Color fundus photograph
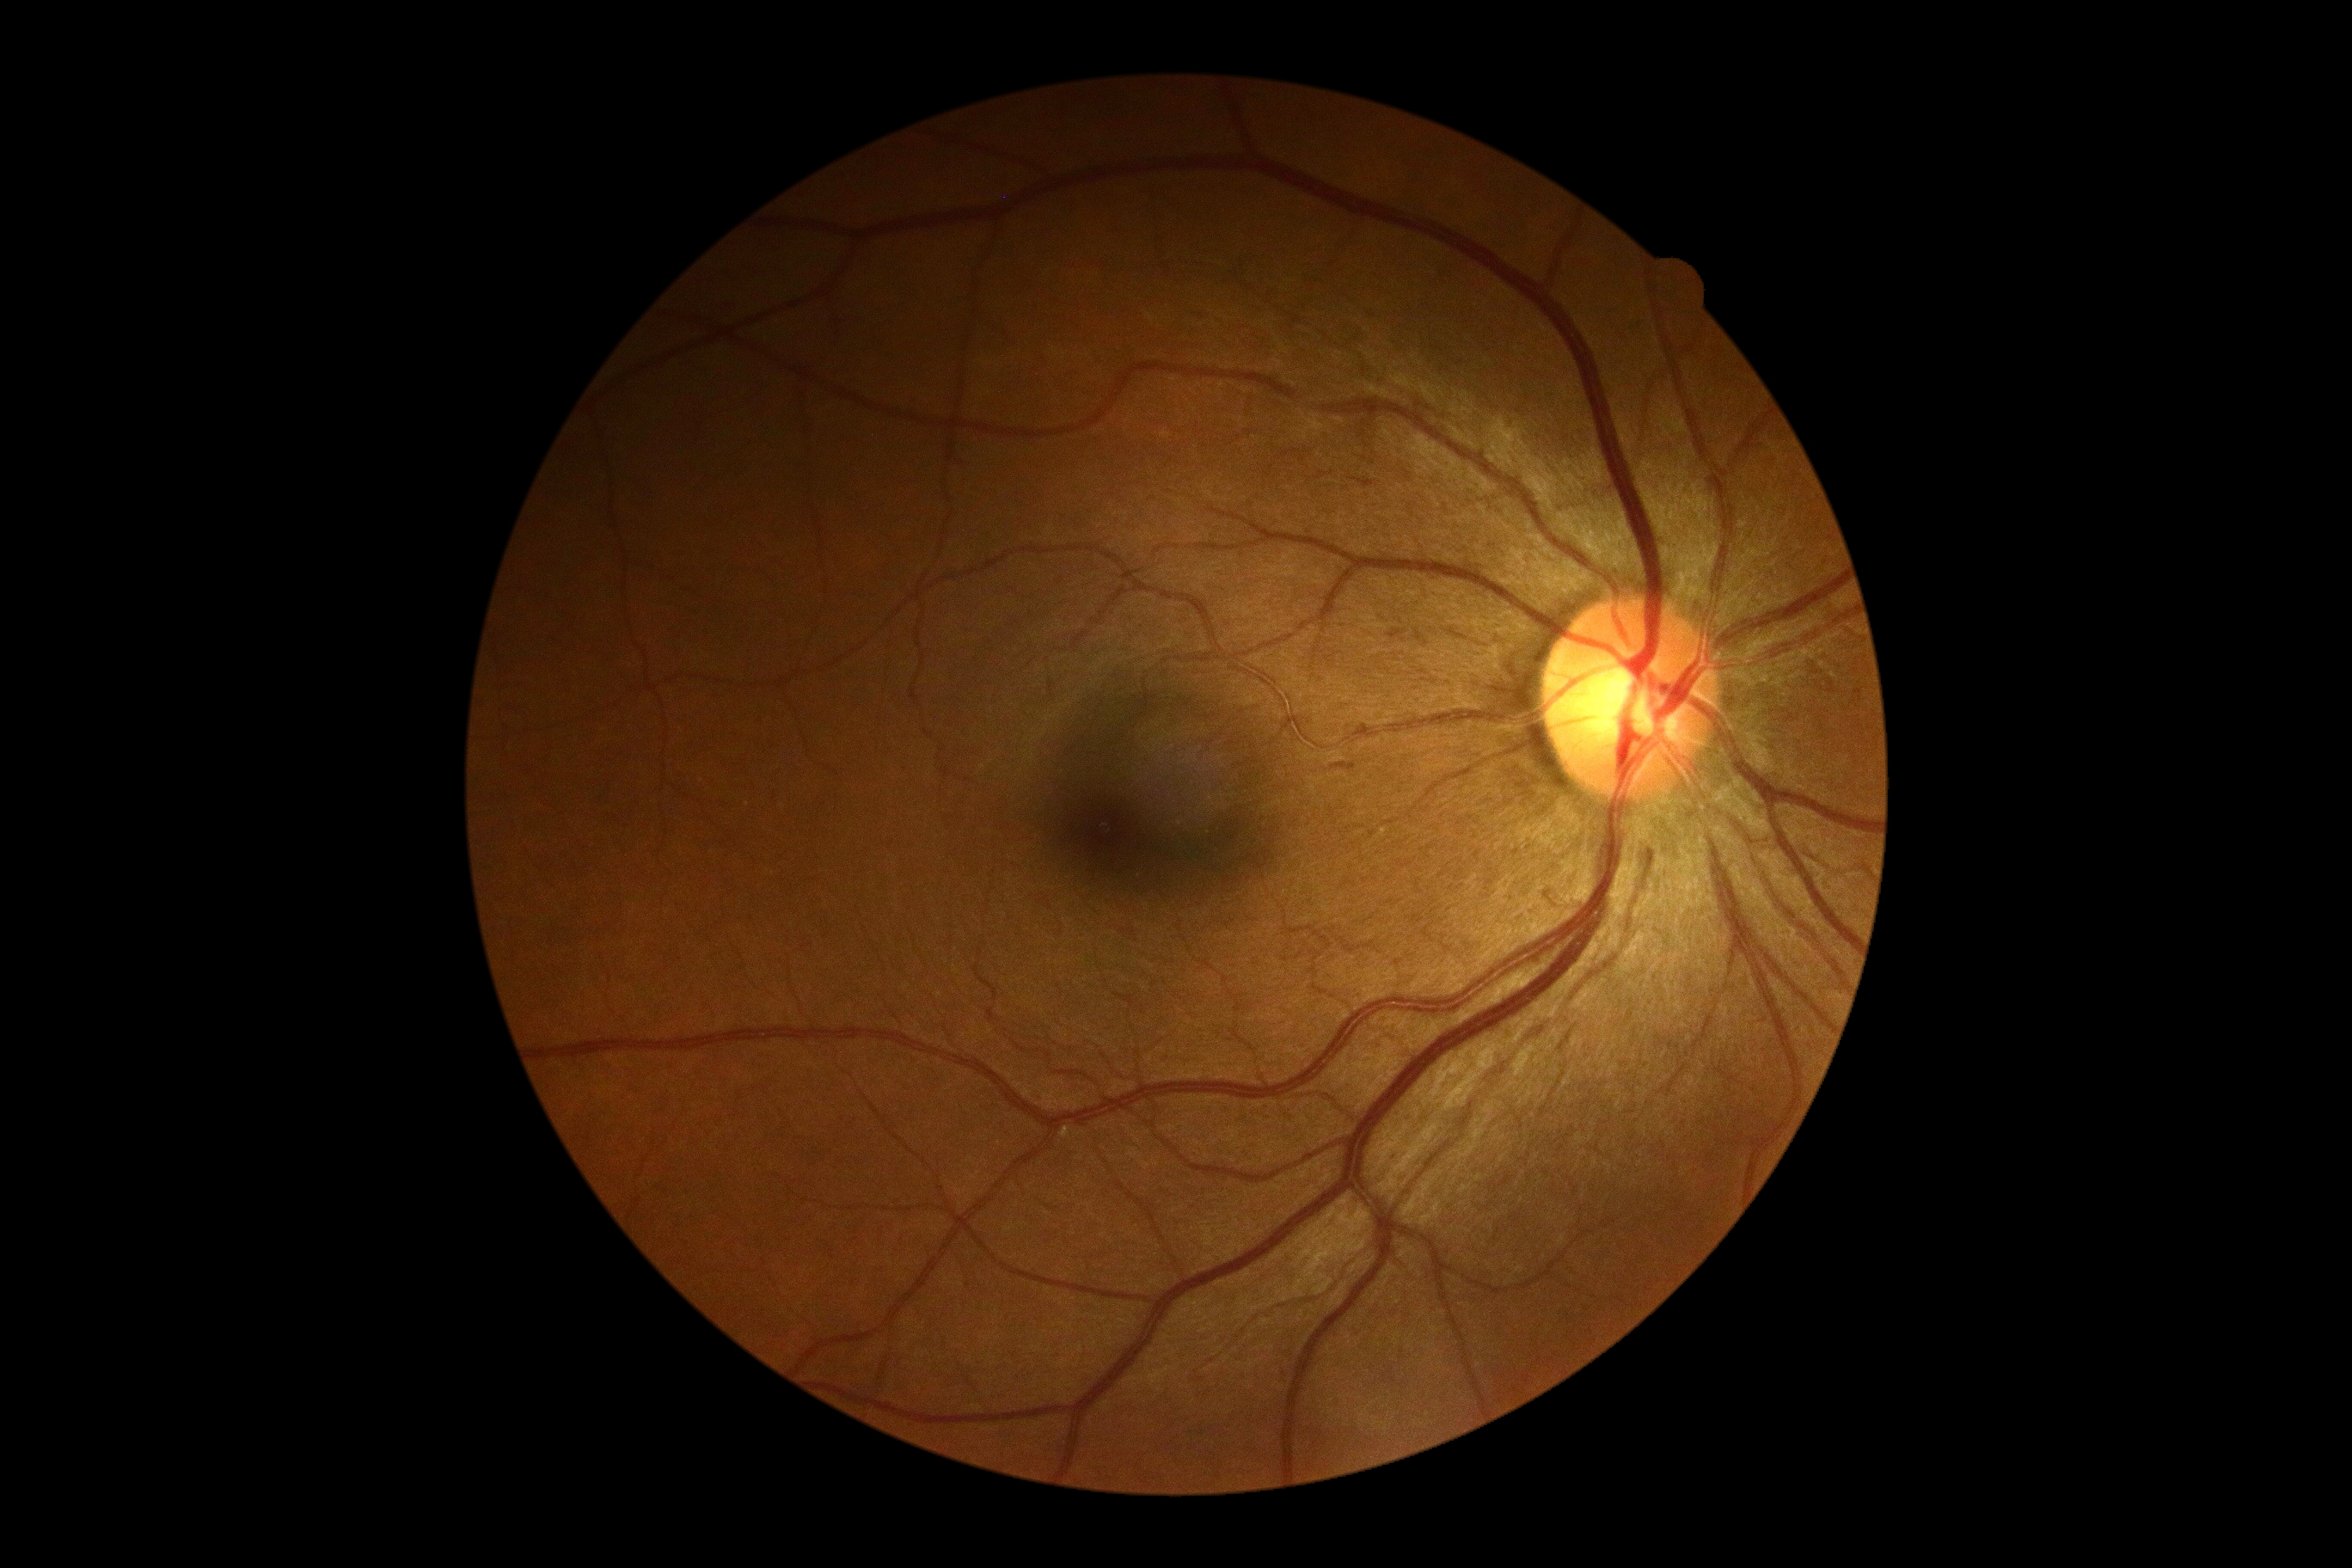
No DR findings. DR severity: 0/4.